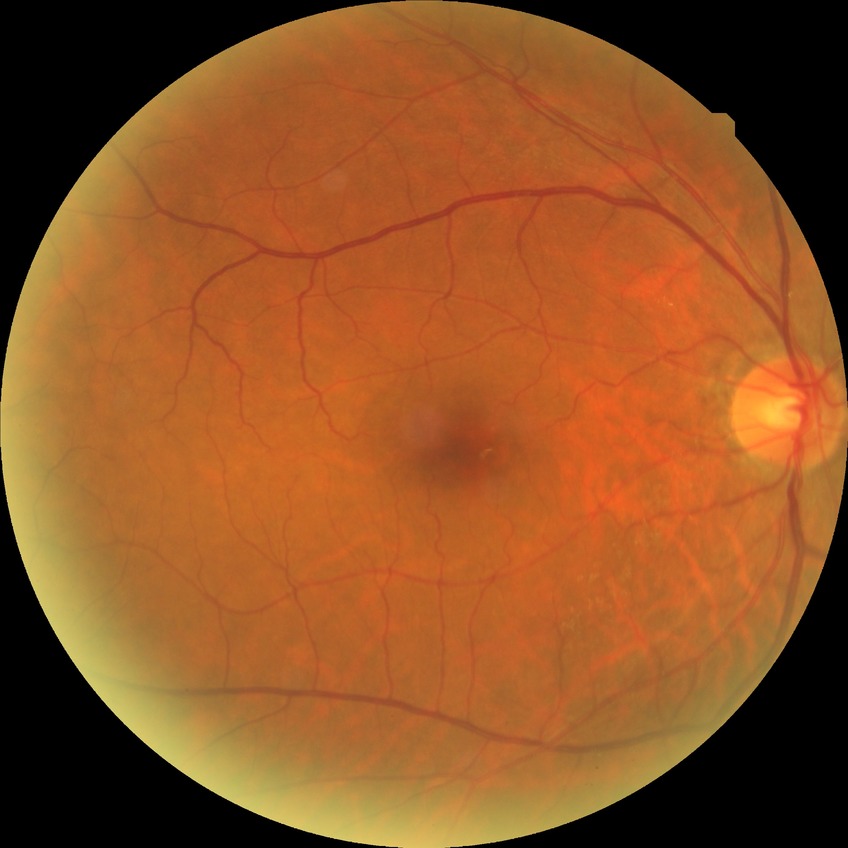

Davis grading: no diabetic retinopathy.